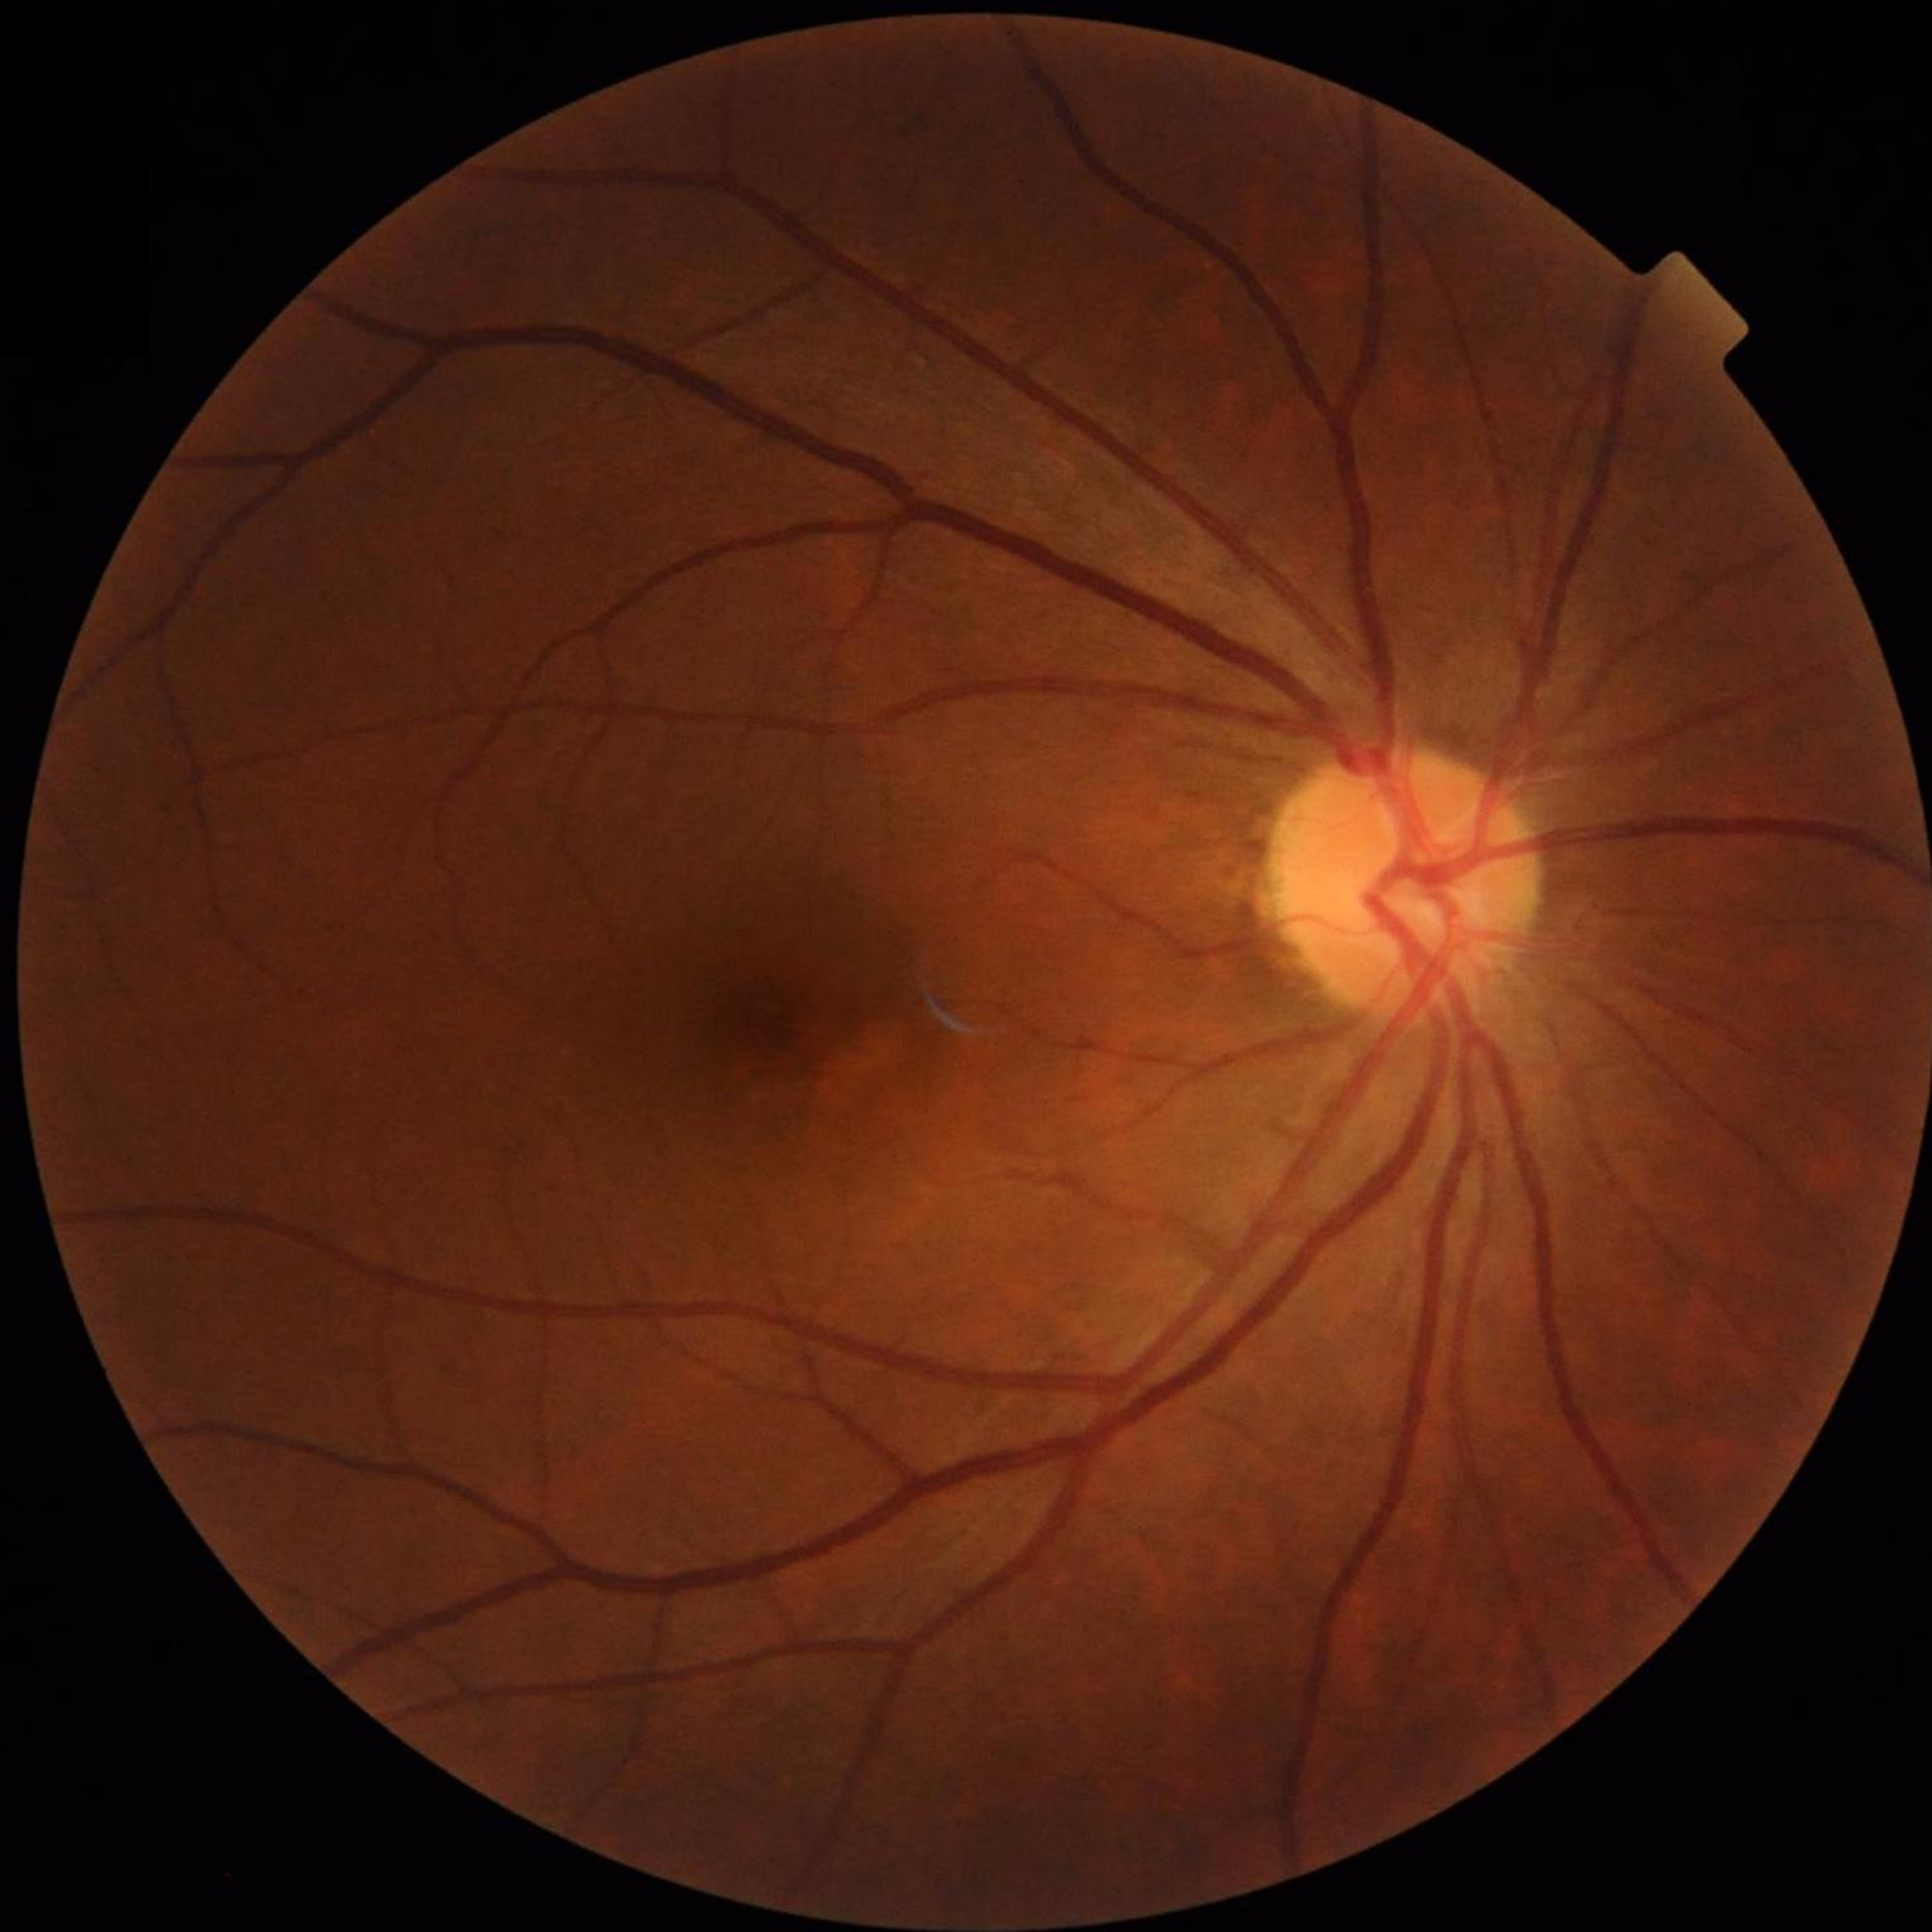 {"diagnosis": "no AMD, DR, or glaucomatous findings", "image_quality": "good"}